Image size 2352x1568, color fundus photograph, 45° FOV:
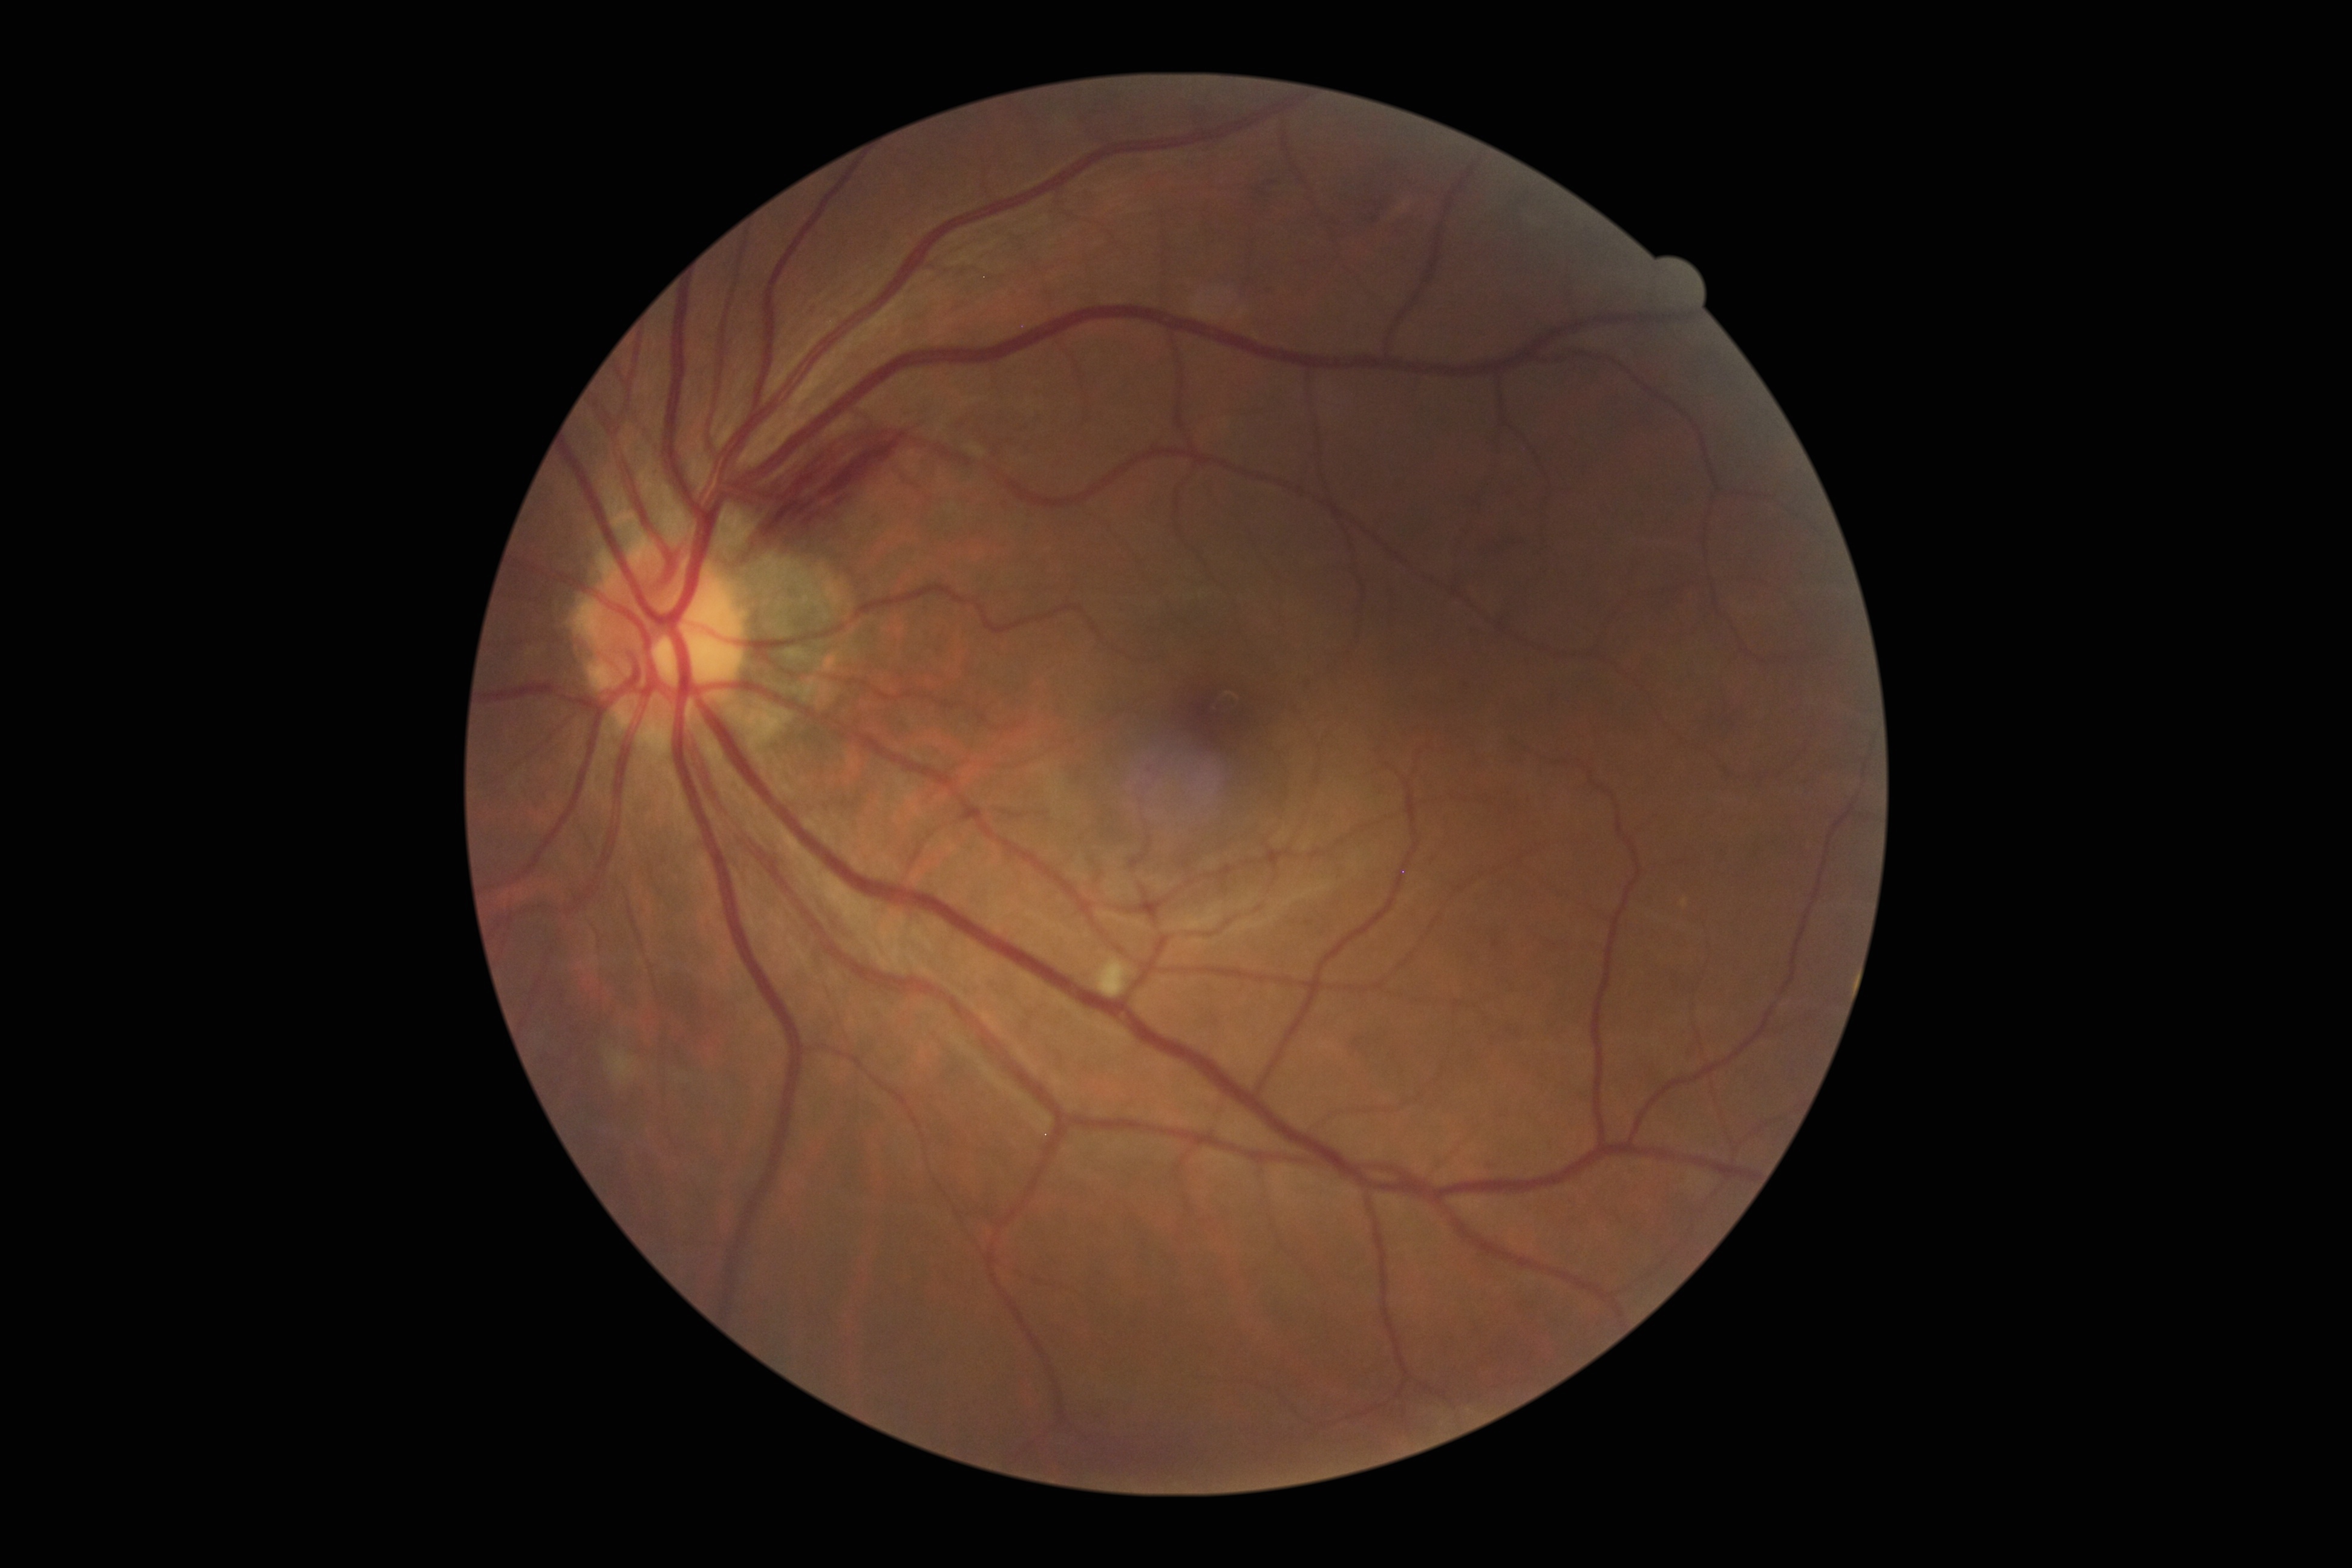

Diabetic retinopathy grade is moderate non-proliferative diabetic retinopathy (2).